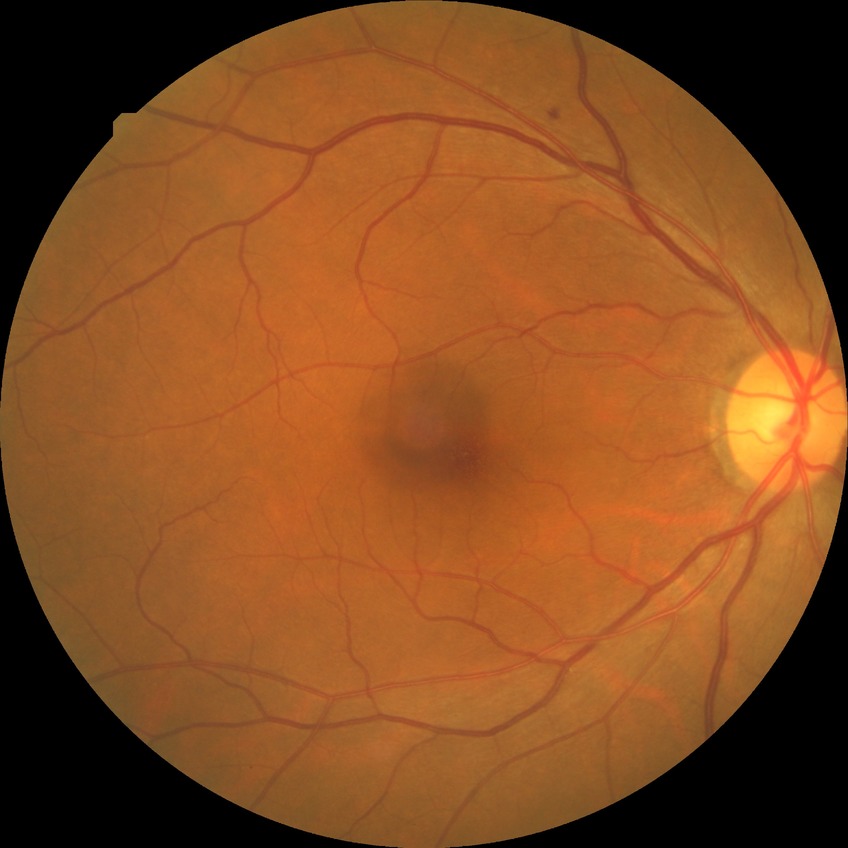
diabetic retinopathy stage: simple diabetic retinopathy.